1240x1240 · infant wide-field retinal image.
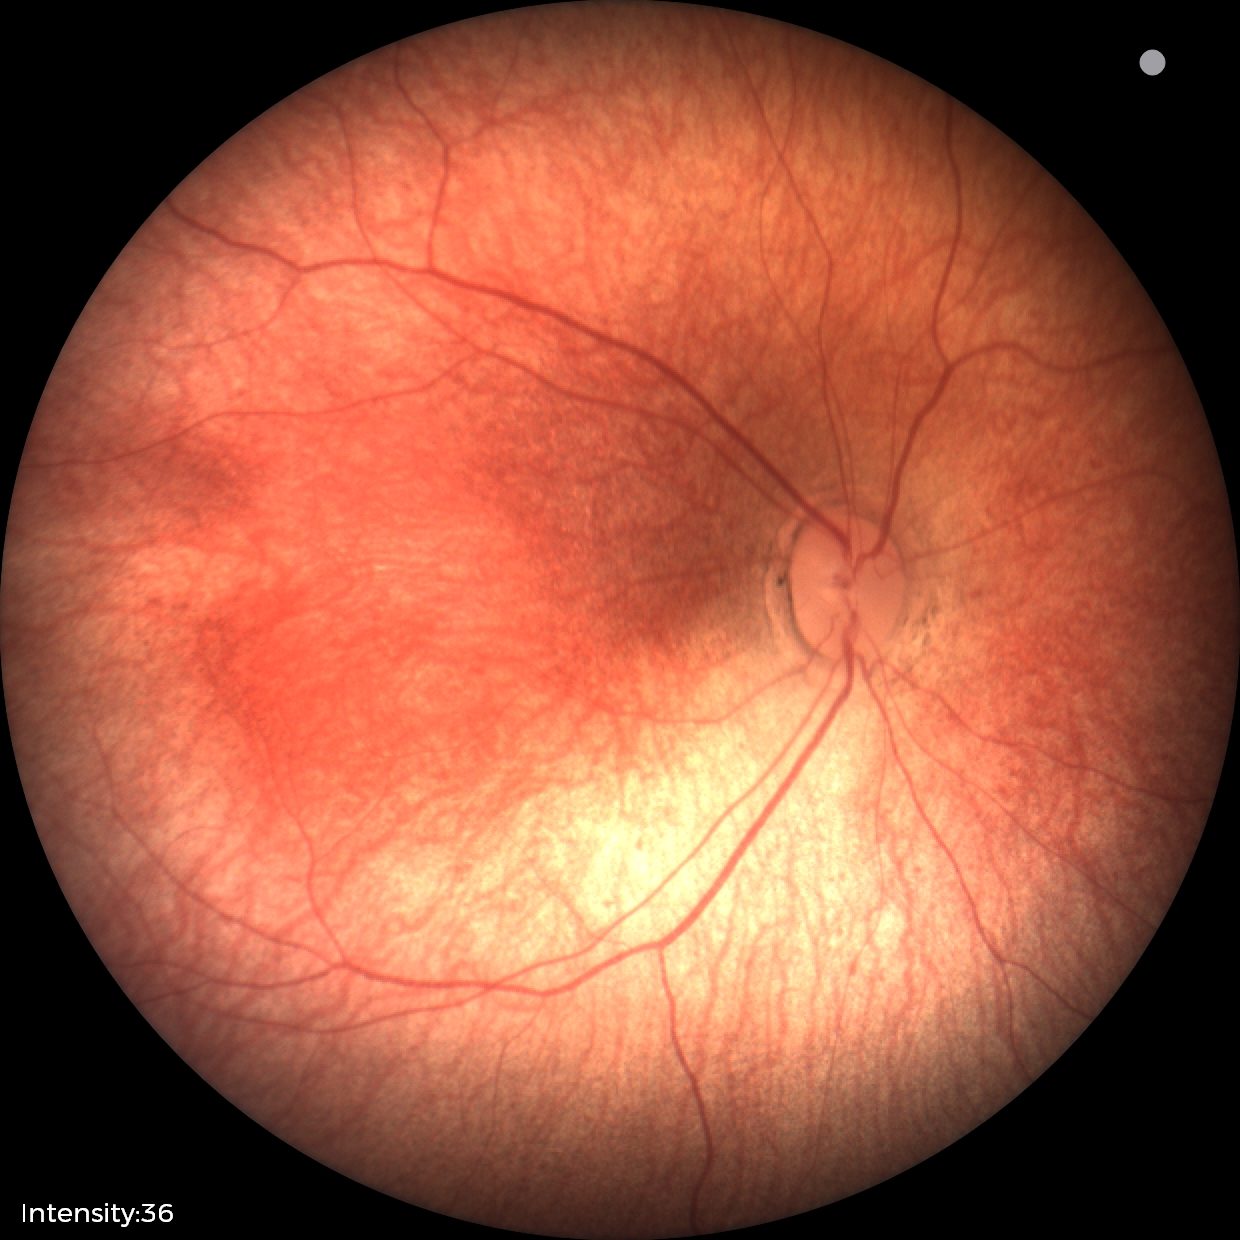
No retinal pathology identified on screening.